FOV: 45 degrees; color fundus image; graded on the modified Davis scale
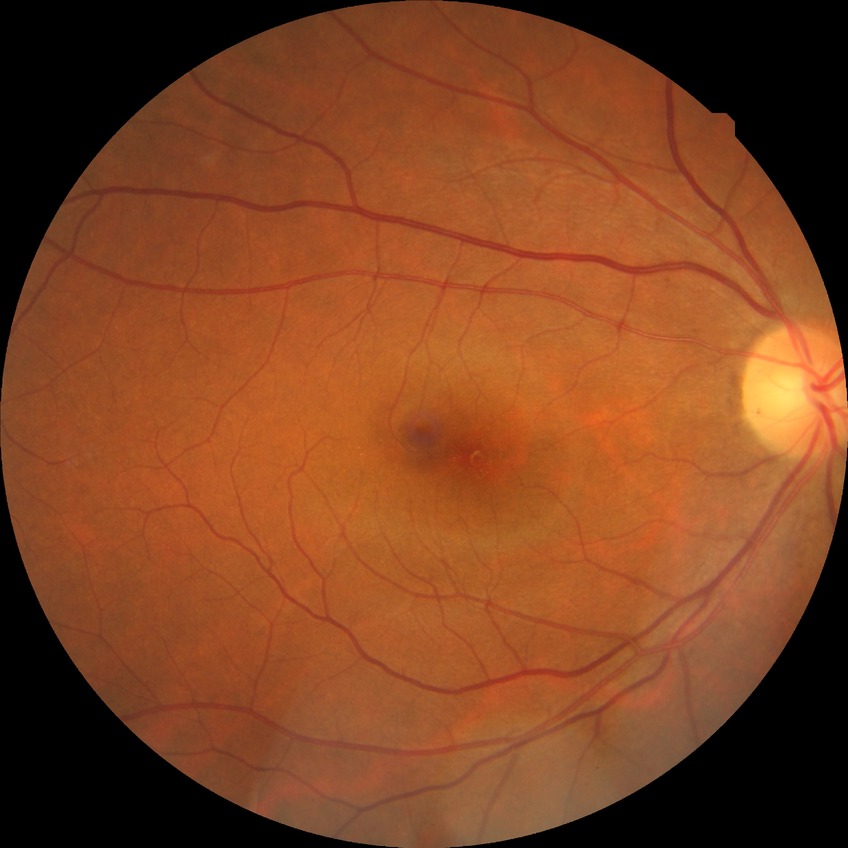
Retinopathy grade: no diabetic retinopathy.